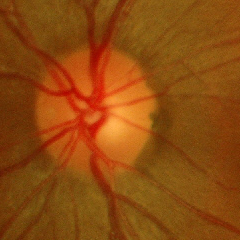
No glaucomatous findings.